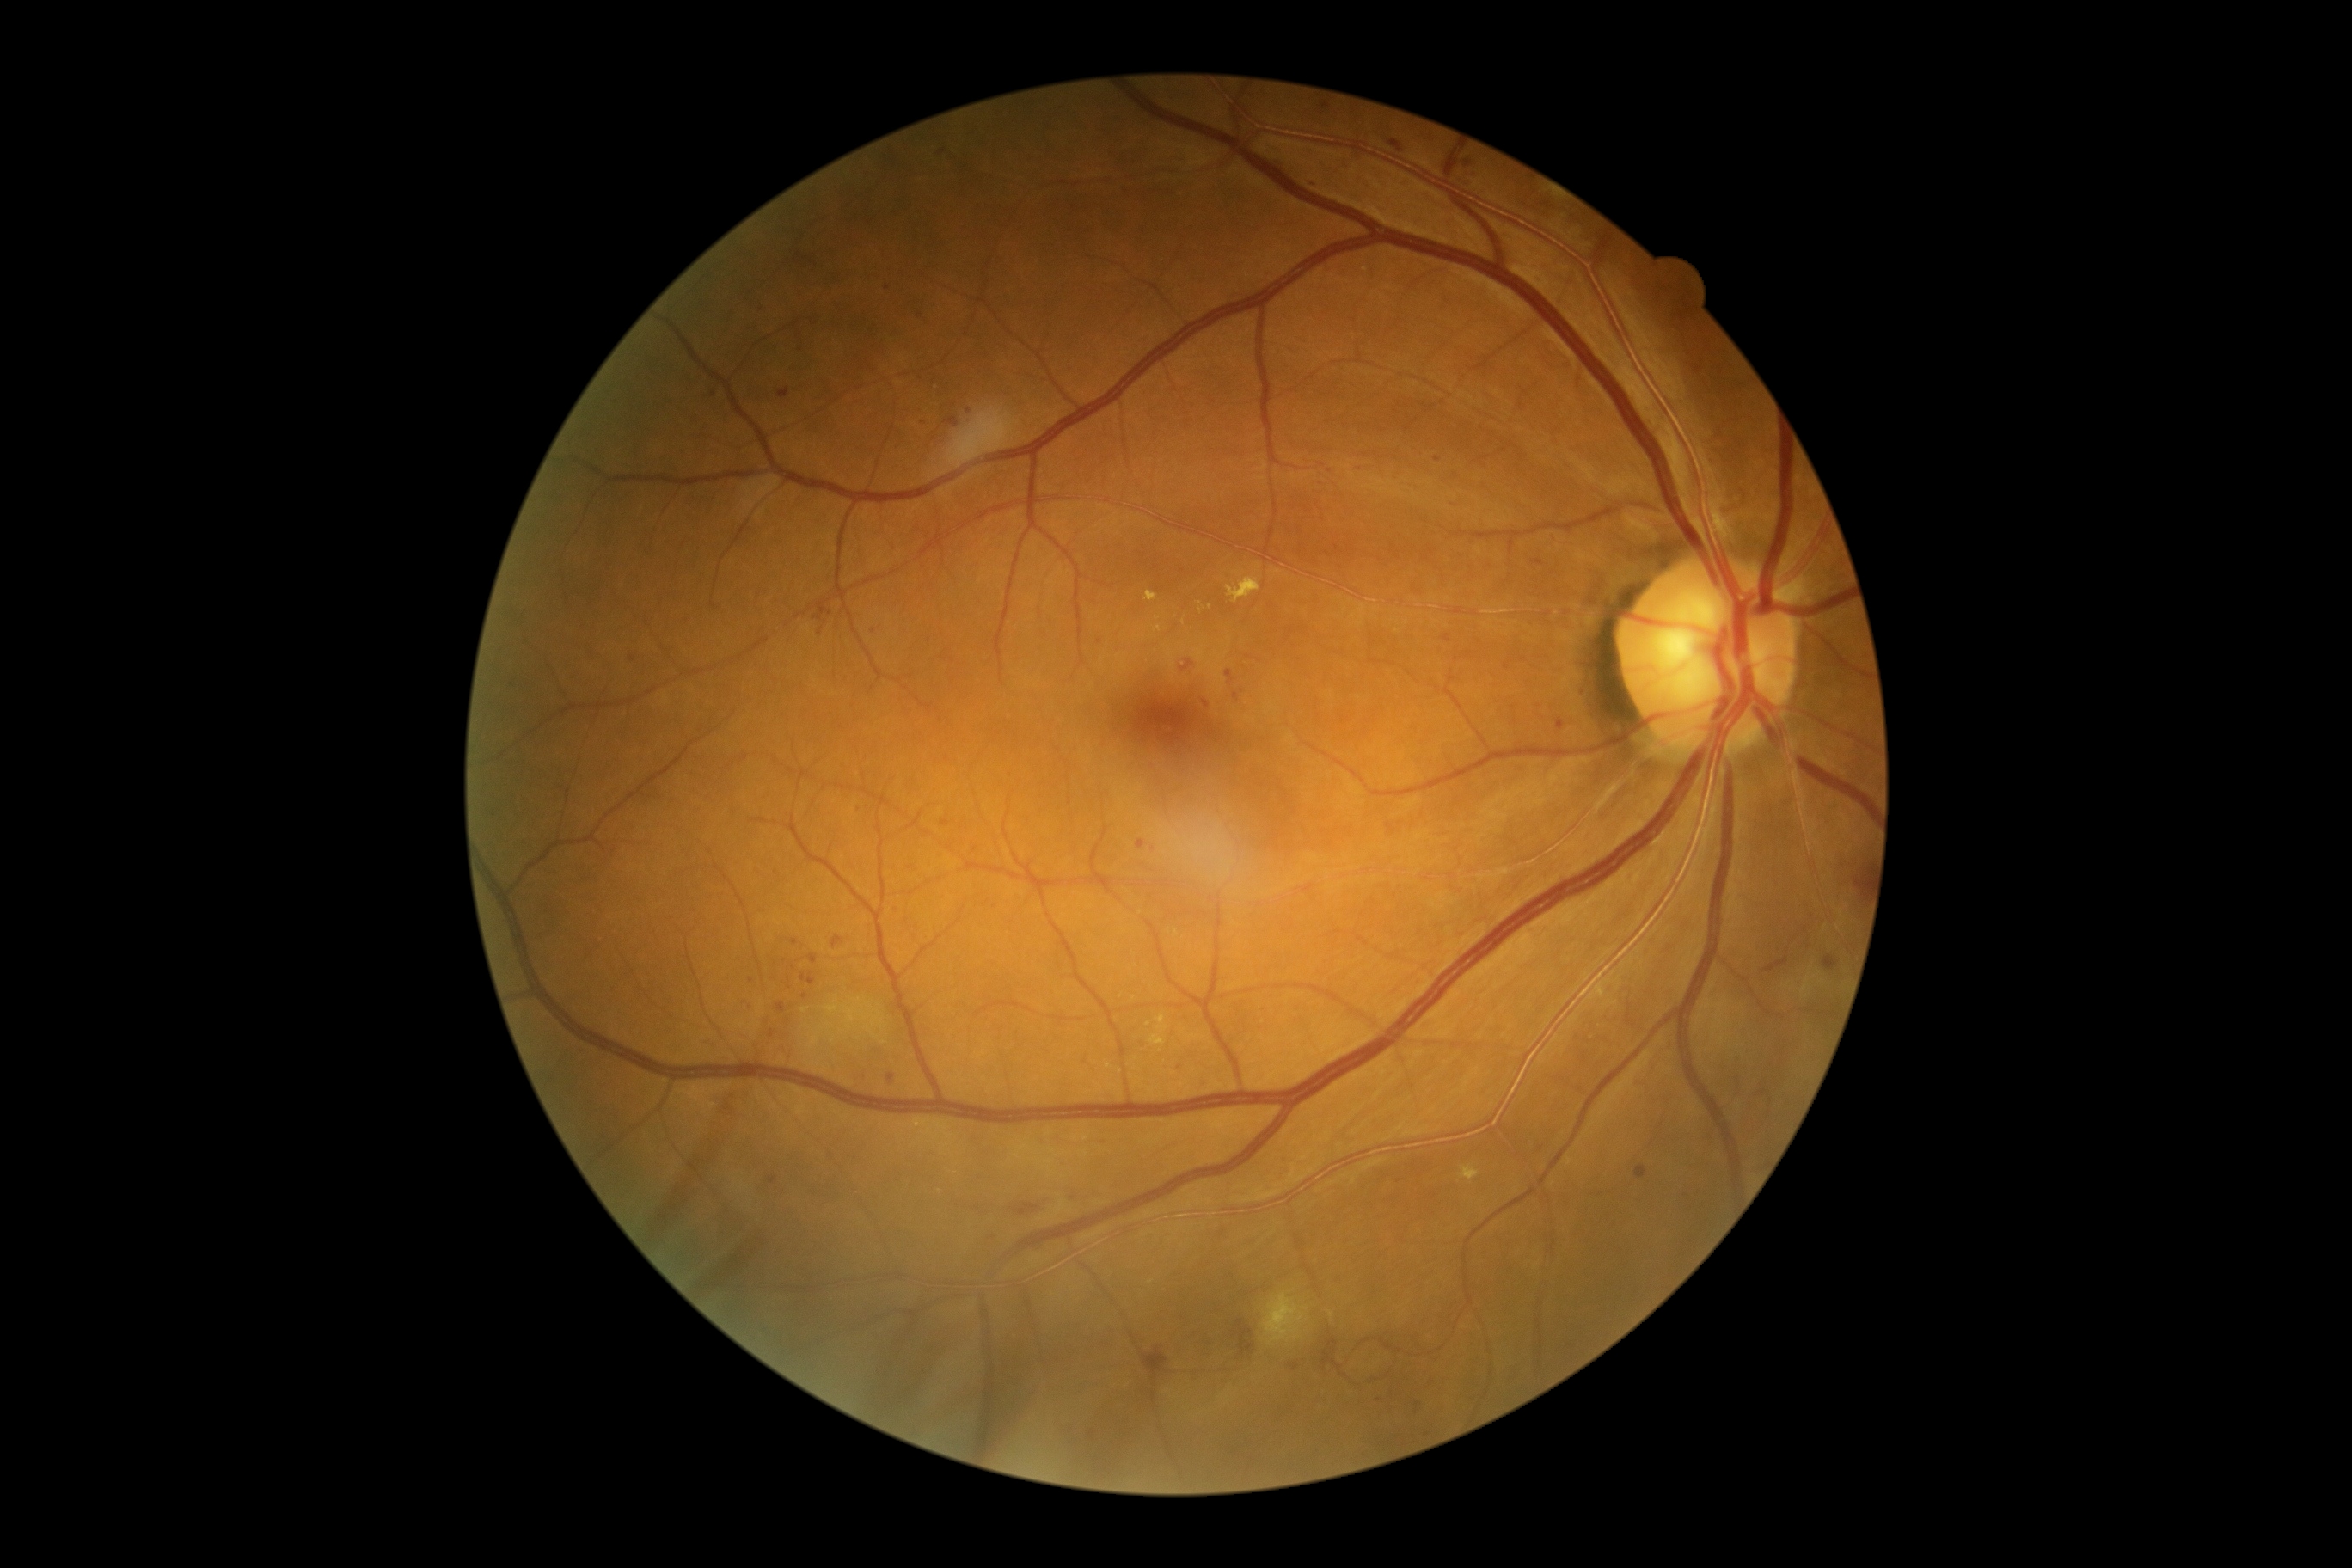
DR grade: 2
Representative lesions:
SEs = absent
HEs = 1142,1347,1168,1387 | 1180,661,1194,671 | 1014,1204,1039,1216 | 1232,1321,1256,1357
EXs (more not shown) = 1263,1292,1309,1347 | 1155,627,1163,634 | 1146,591,1158,603 | 1156,1015,1168,1032 | 1227,577,1261,604 | 1461,1167,1479,1182 | 1149,1036,1167,1046
Small EXs near [x=1211, y=607] | [x=900, y=1125] | [x=1152, y=1282] | [x=1201, y=611] | [x=1332, y=1316] | [x=1149, y=1025] | [x=1161, y=1051]
MAs (more not shown) = 1533,560,1543,567 | 1089,1431,1096,1440 | 1290,1364,1299,1373 | 1227,670,1235,685 | 776,1003,787,1014 | 809,955,819,964 | 943,417,959,427 | 831,936,843,950 | 1311,181,1320,188 | 800,974,816,986 | 814,604,833,622
Small MAs near [x=632, y=659] | [x=821, y=631] | [x=1524, y=660] | [x=919, y=315] | [x=795, y=943] | [x=975, y=850] | [x=793, y=969] | [x=804, y=997] | [x=1180, y=1068]